45-degree field of view, 2048x1536 — 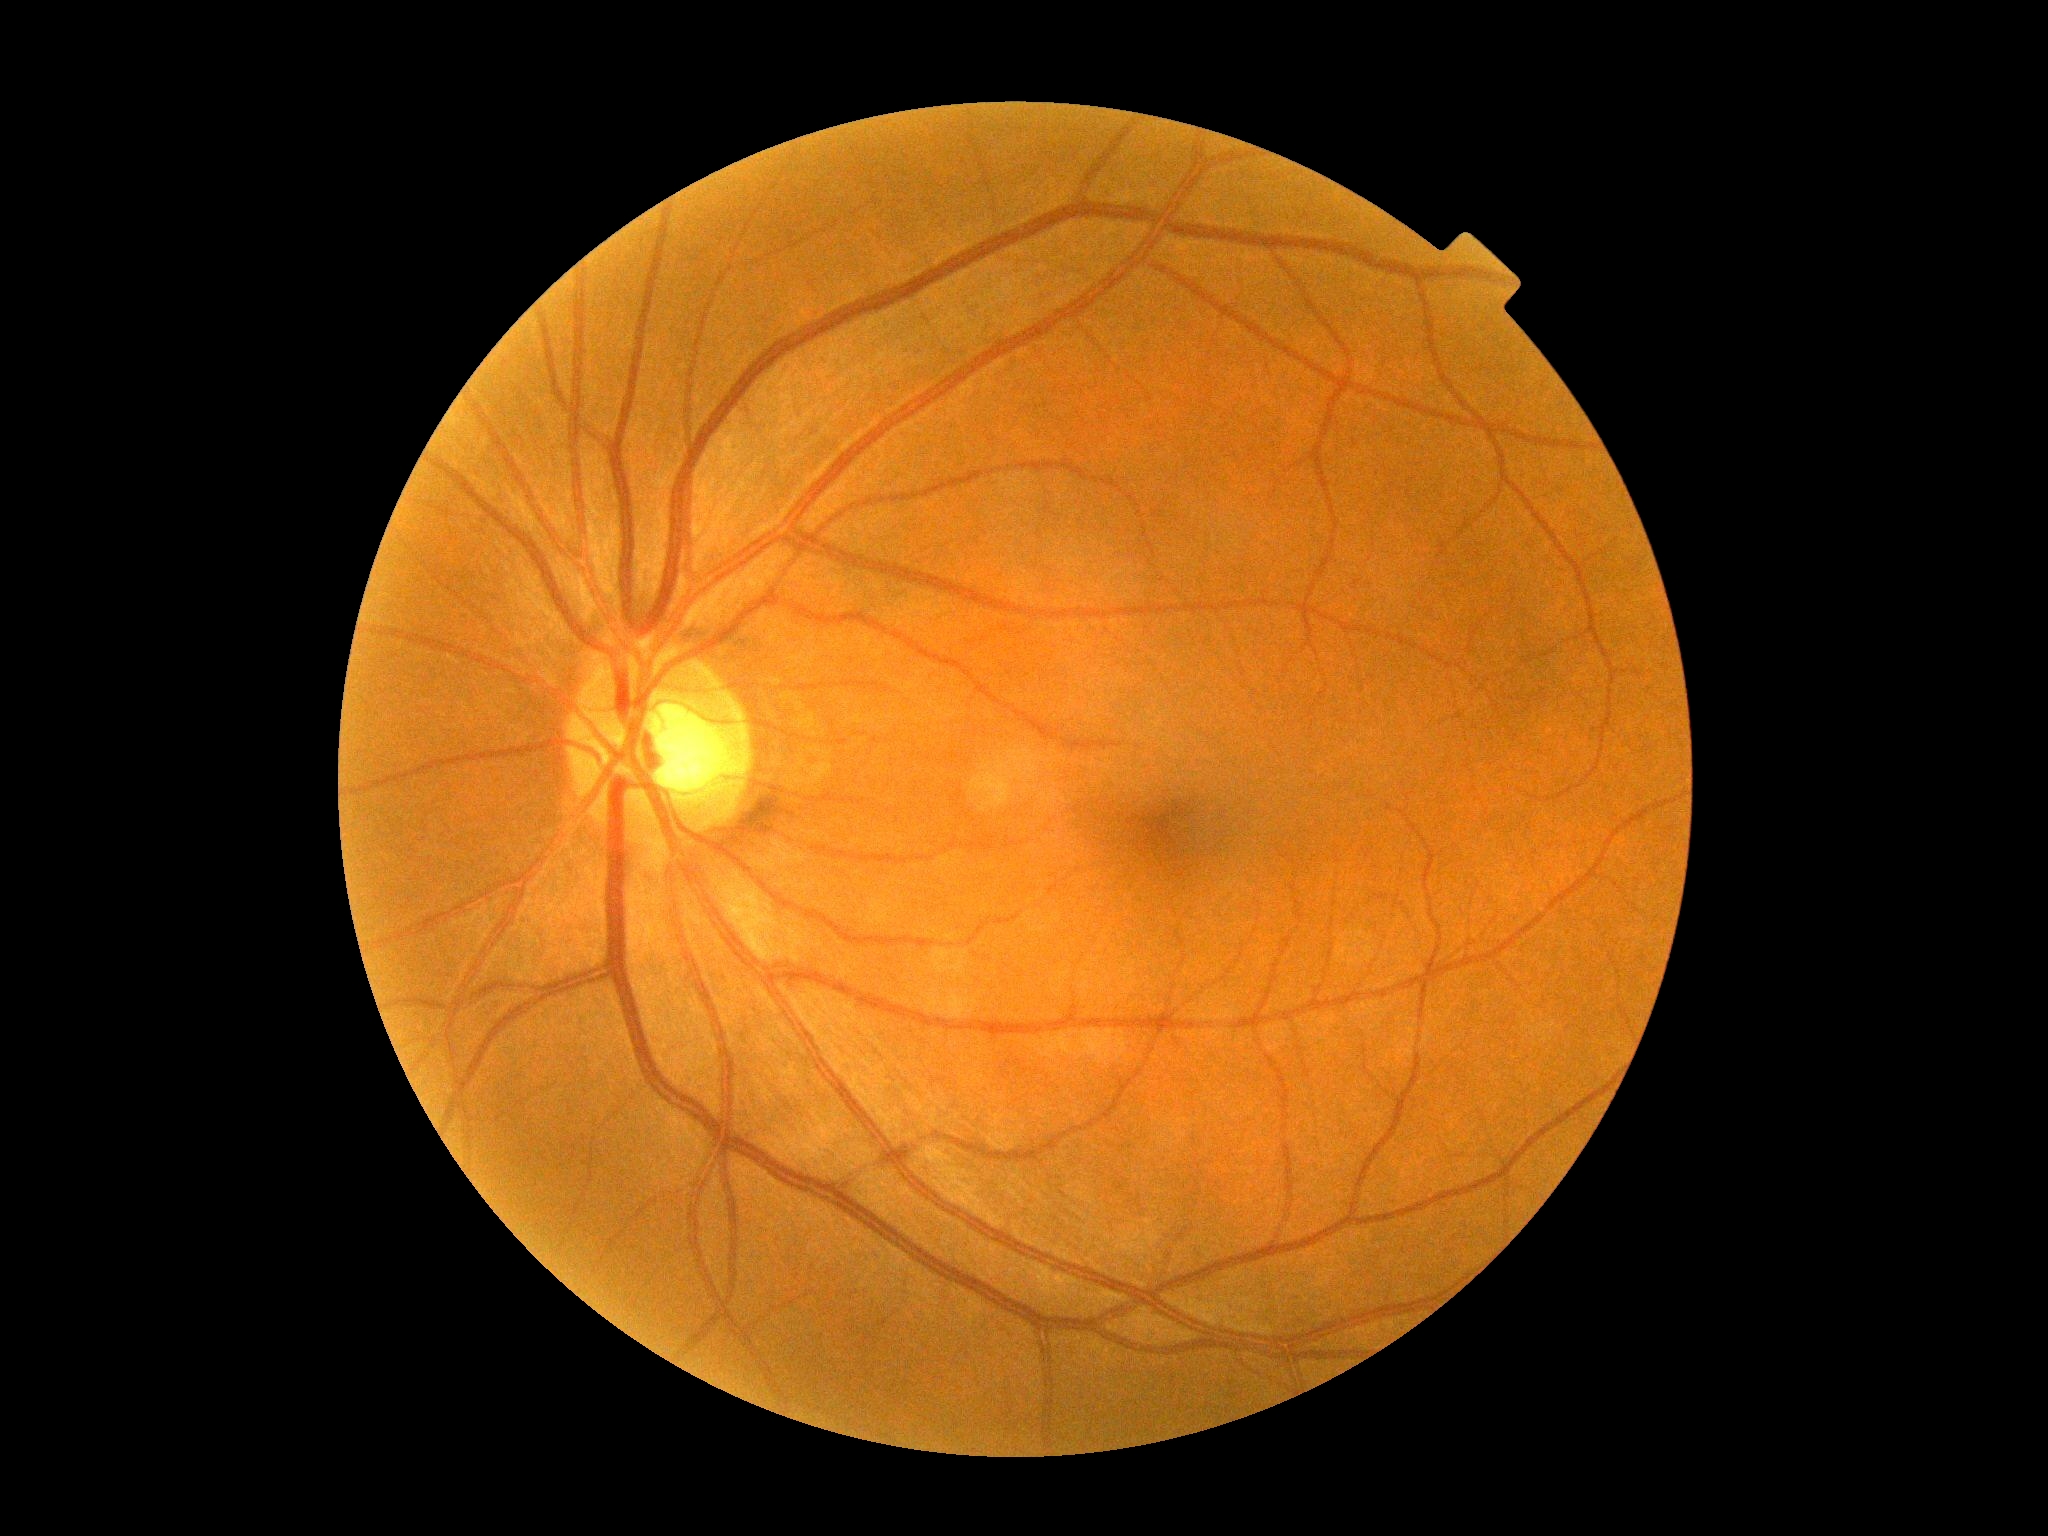
{
  "dr_grade": "grade 0 (no apparent retinopathy) — no visible signs of diabetic retinopathy",
  "dr_impression": "negative for DR"
}